FOV: 45 degrees, image size 2352x1568: 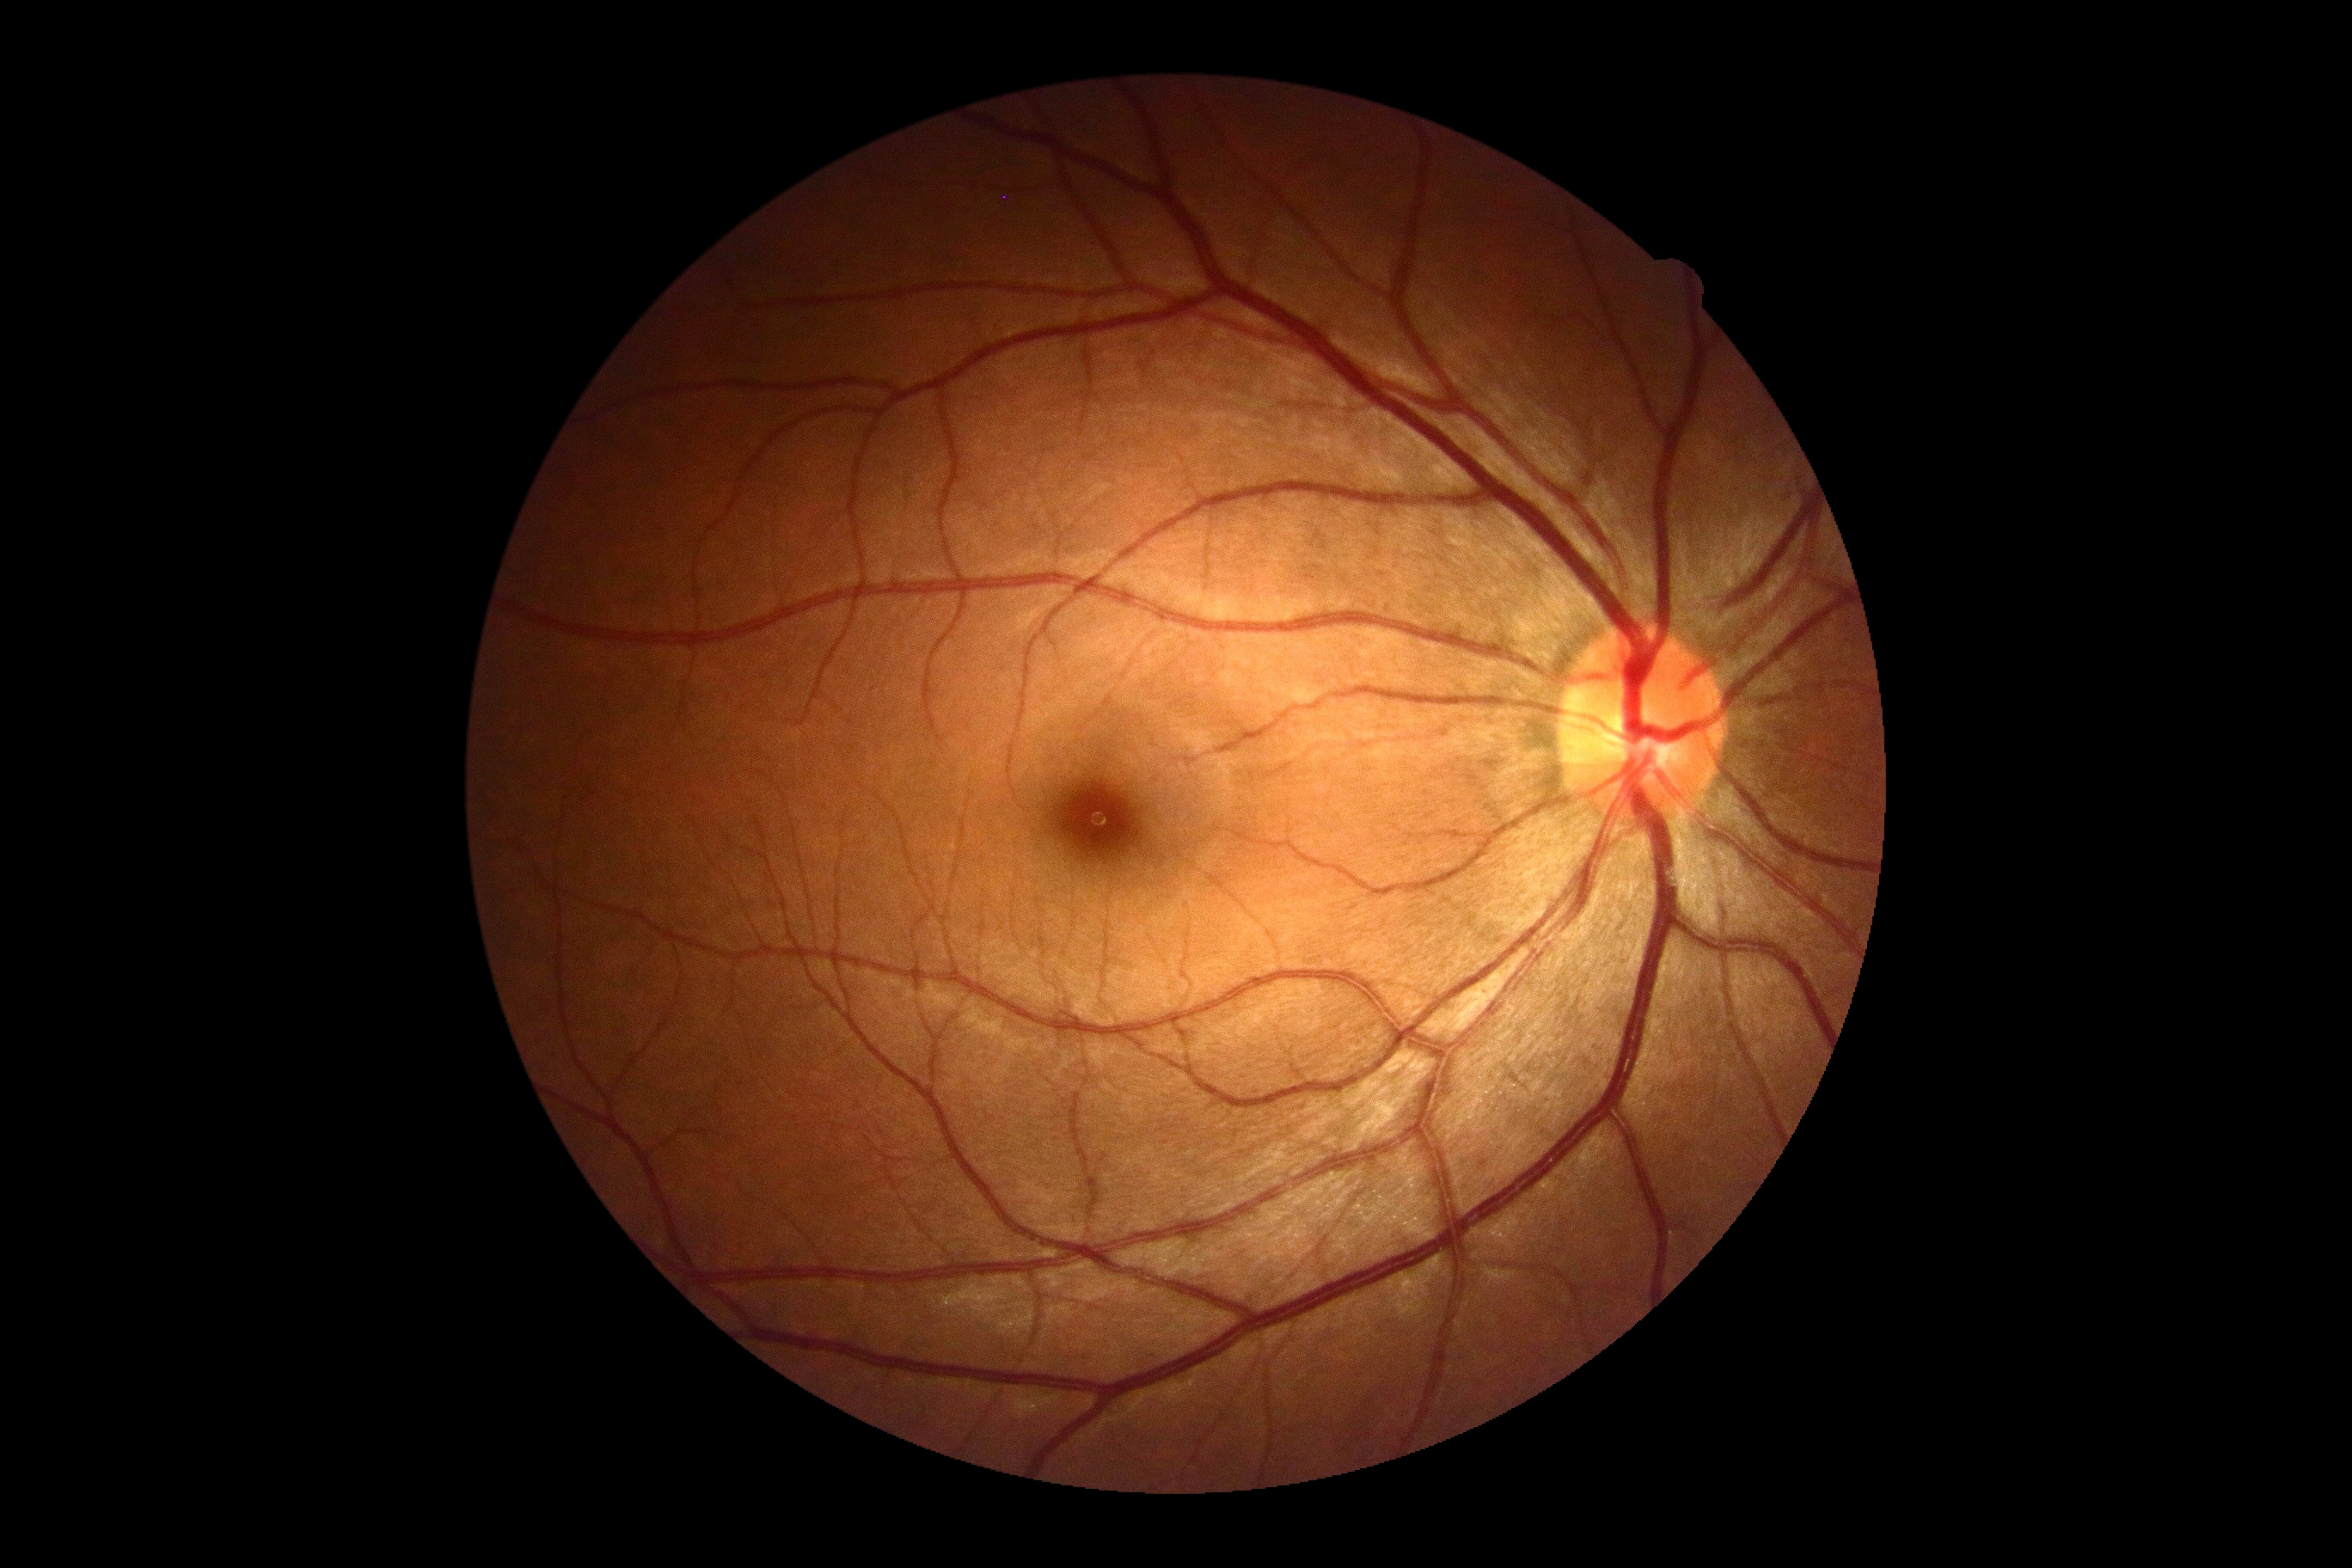
Findings:
• DR severity: 0/4